Wide-field contact fundus photograph of an infant; image size 640x480
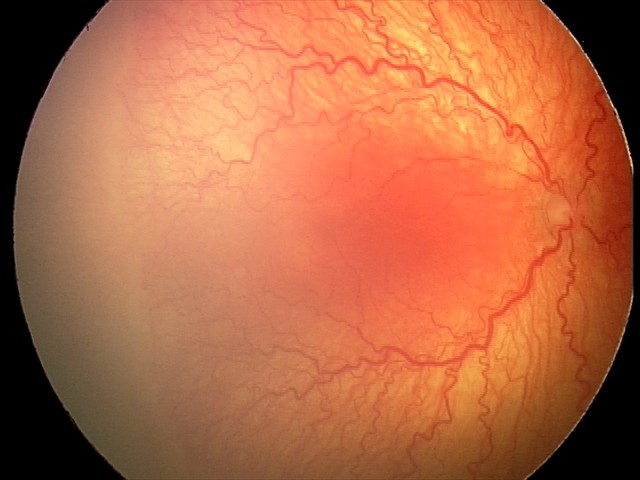 Screening: A-ROP (aggressive ROP) — rapidly progressive severe ROP with prominent plus disease, often without classic stage progression.